1240 by 1240 pixels. Wide-field fundus image from infant ROP screening
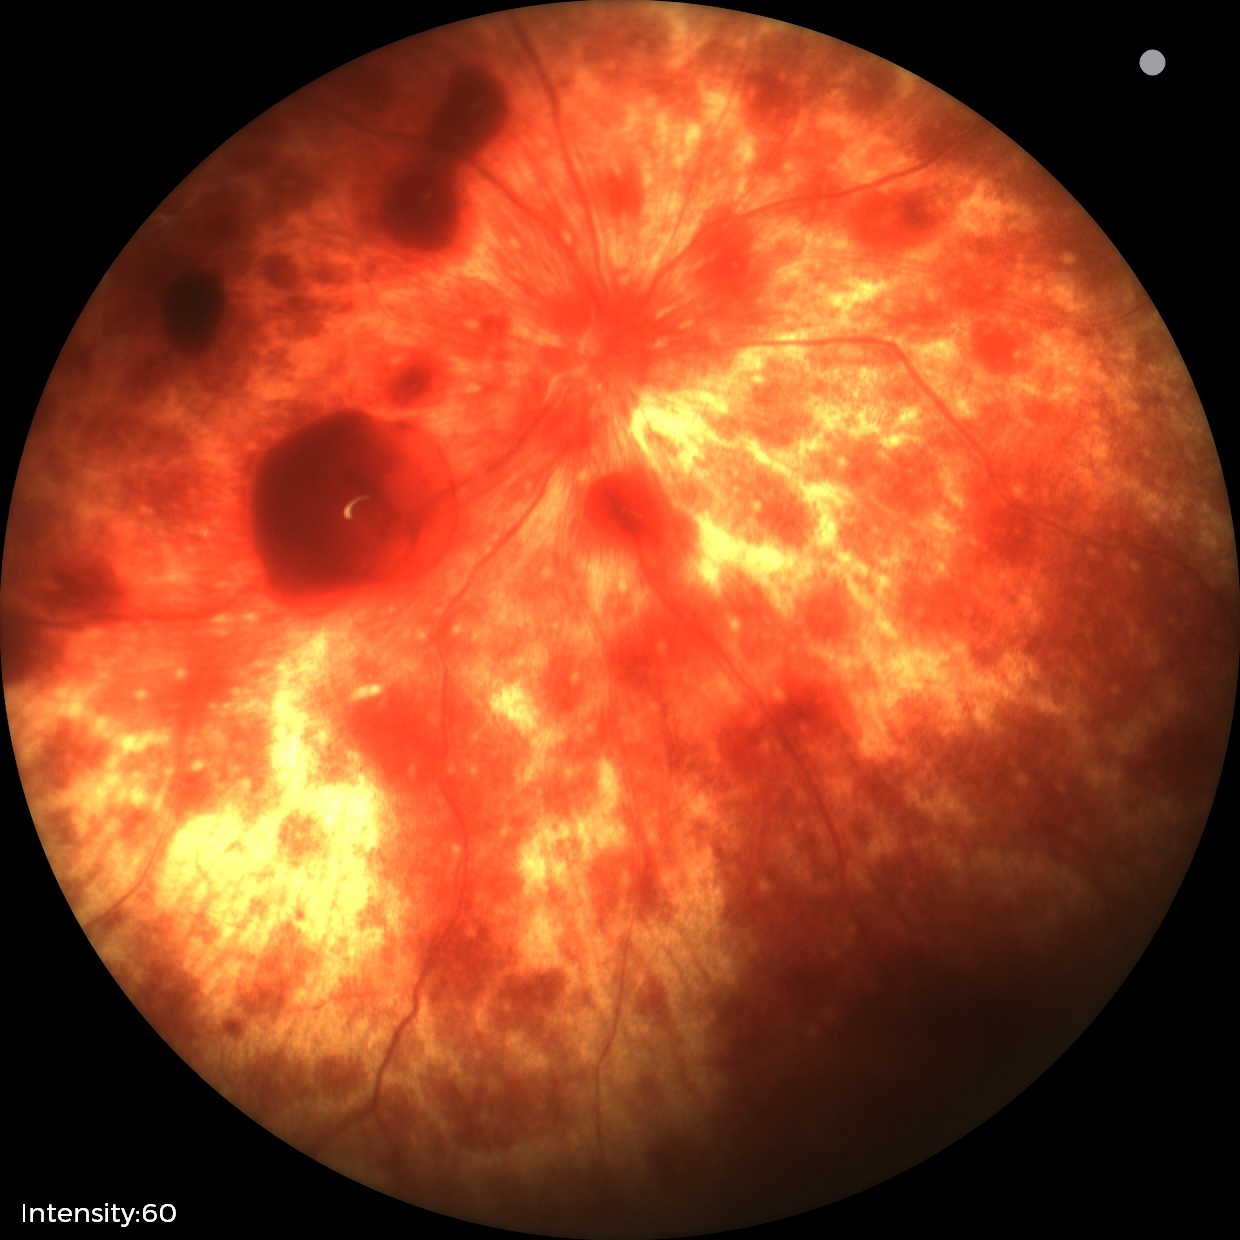

From an examination with diagnosis of retinal hemorrhages.